Color fundus photograph · 45-degree field of view · 2048x1536
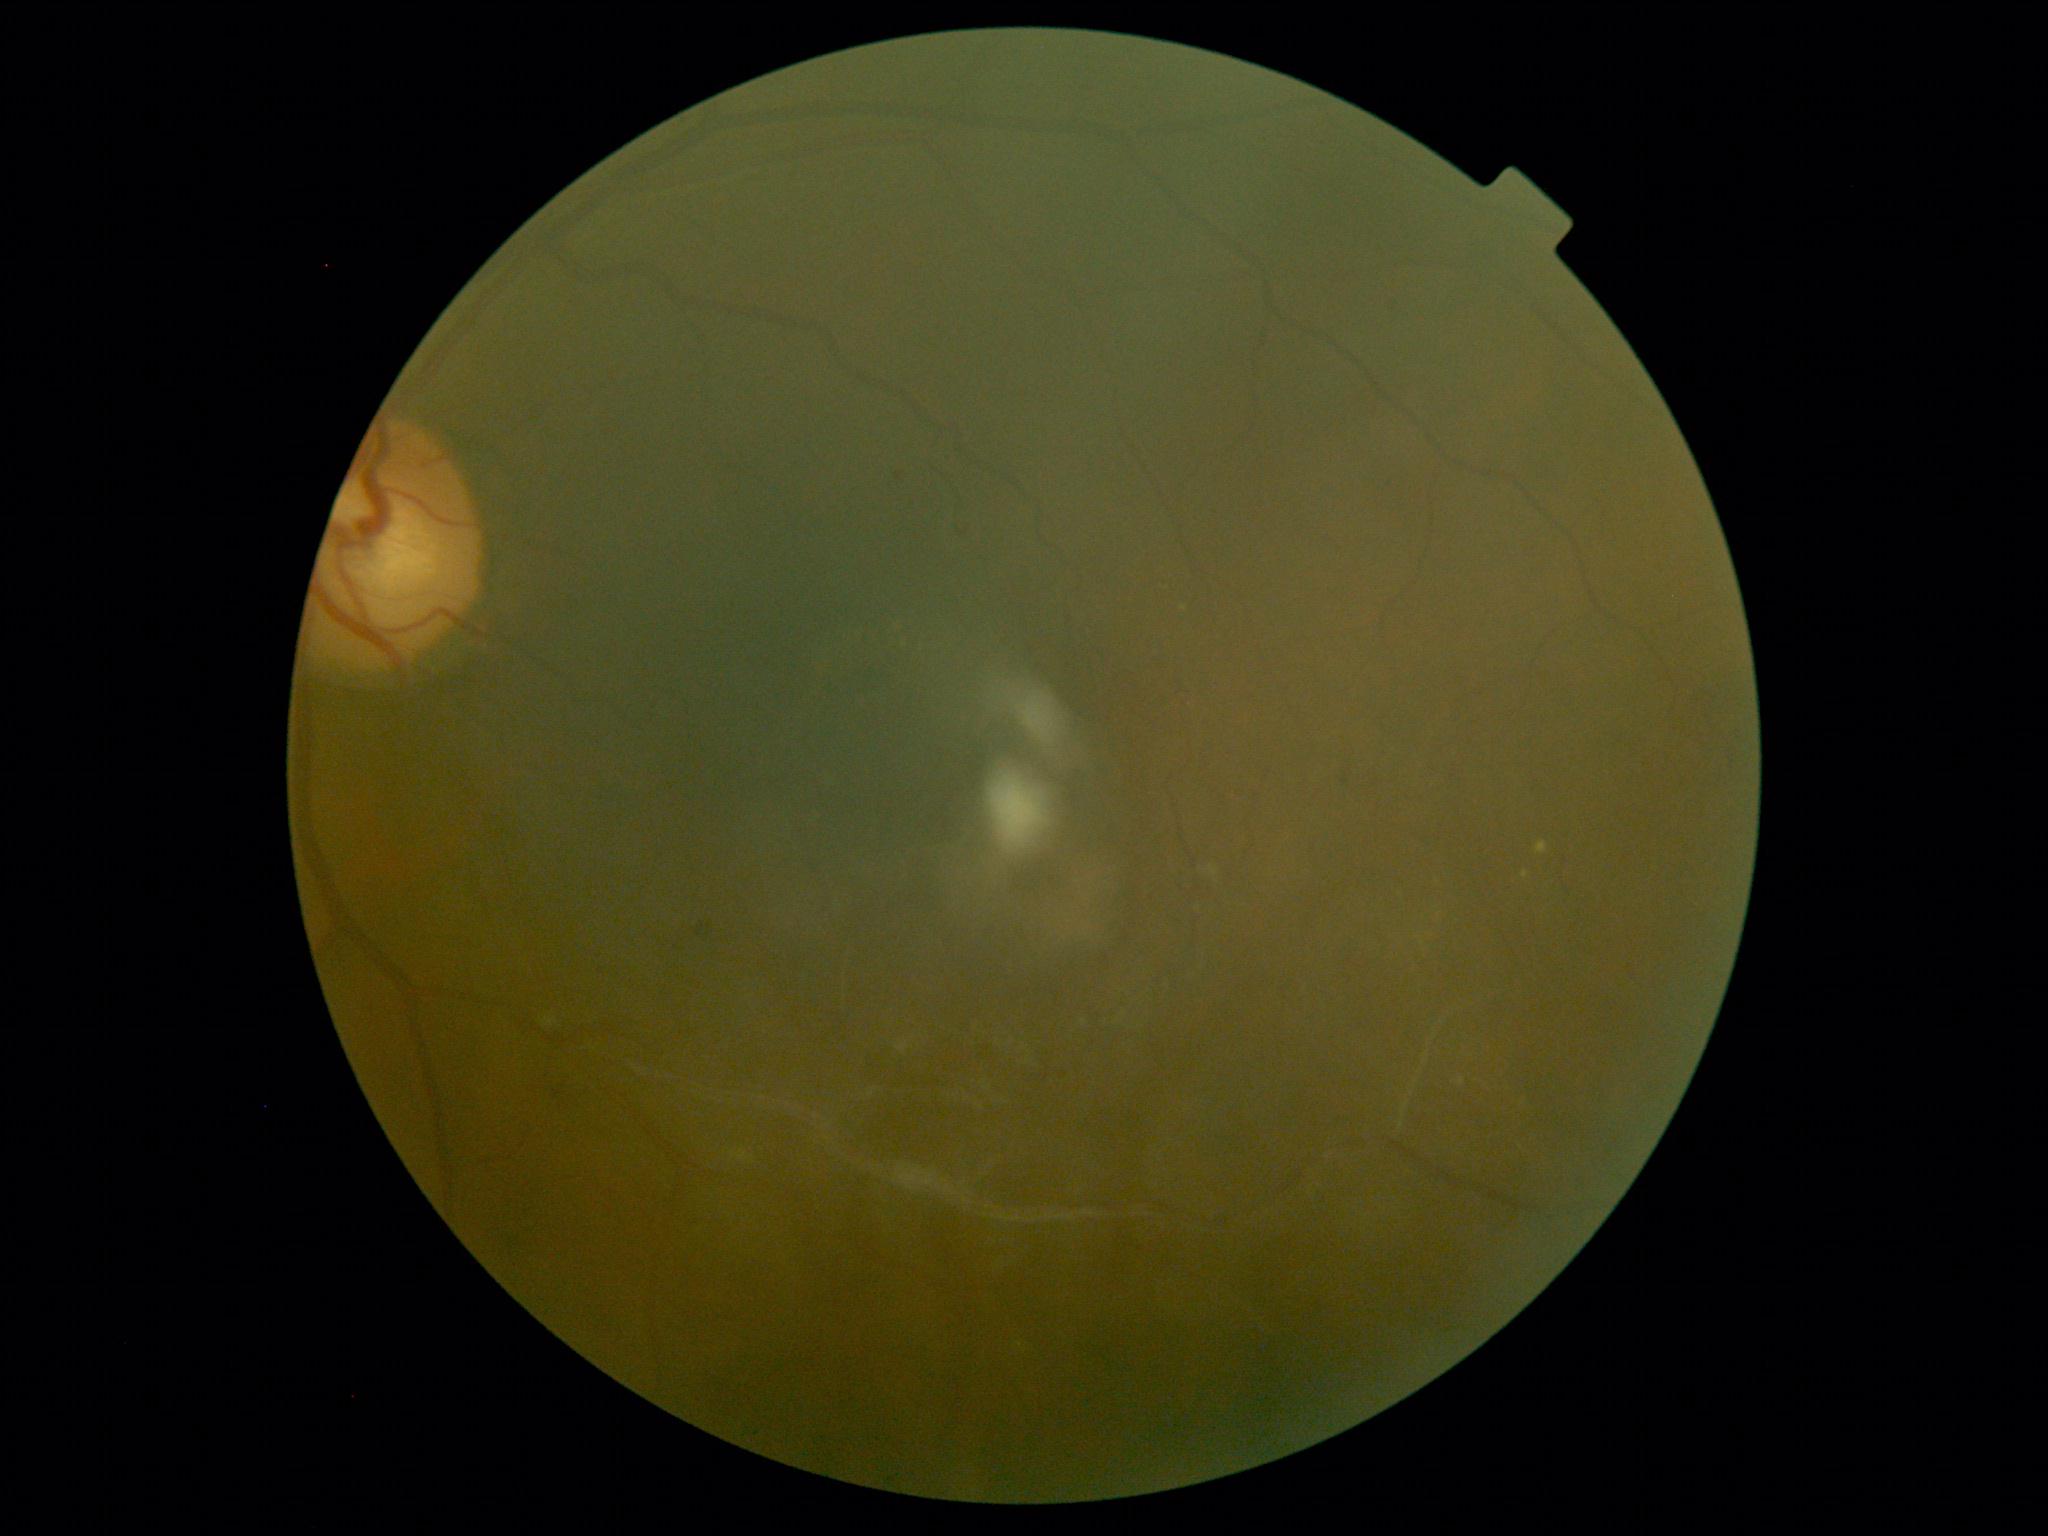 DR severity: moderate NPDR (grade 2).